FOV: 45 degrees. Fundus photo. Image size 1932x1916:
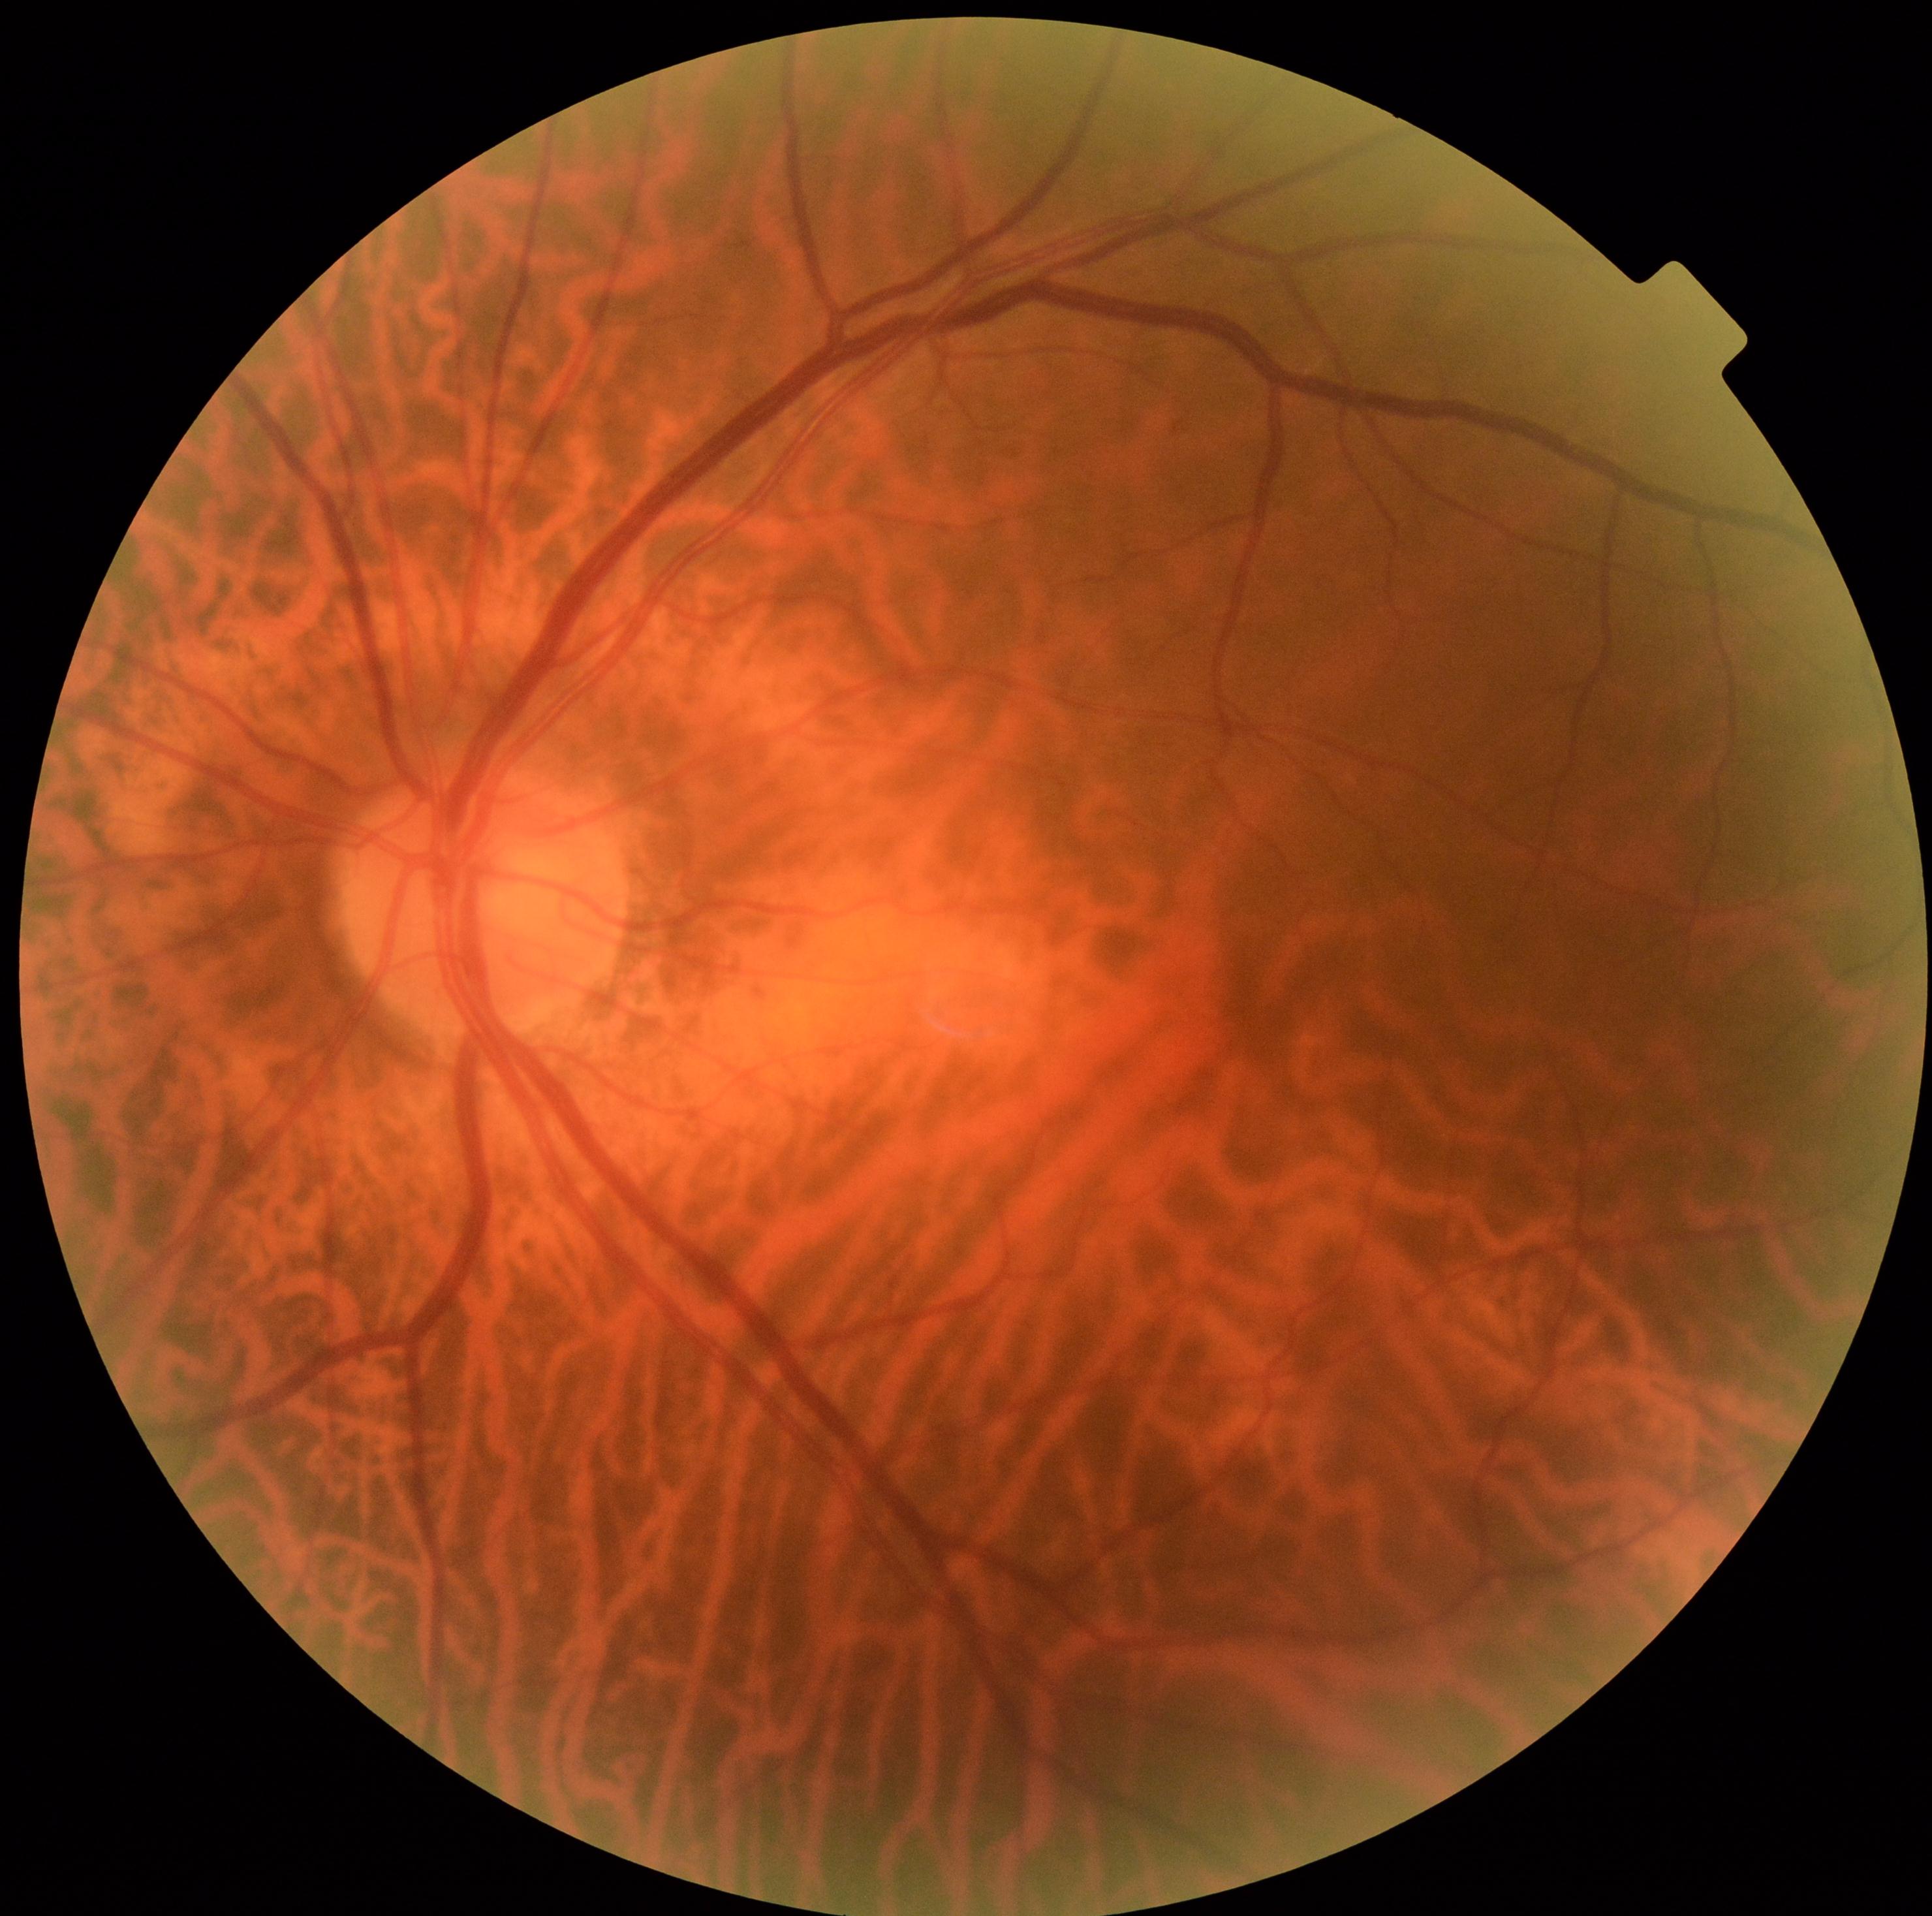 - DR impression — no DR findings
- DR grade — 0